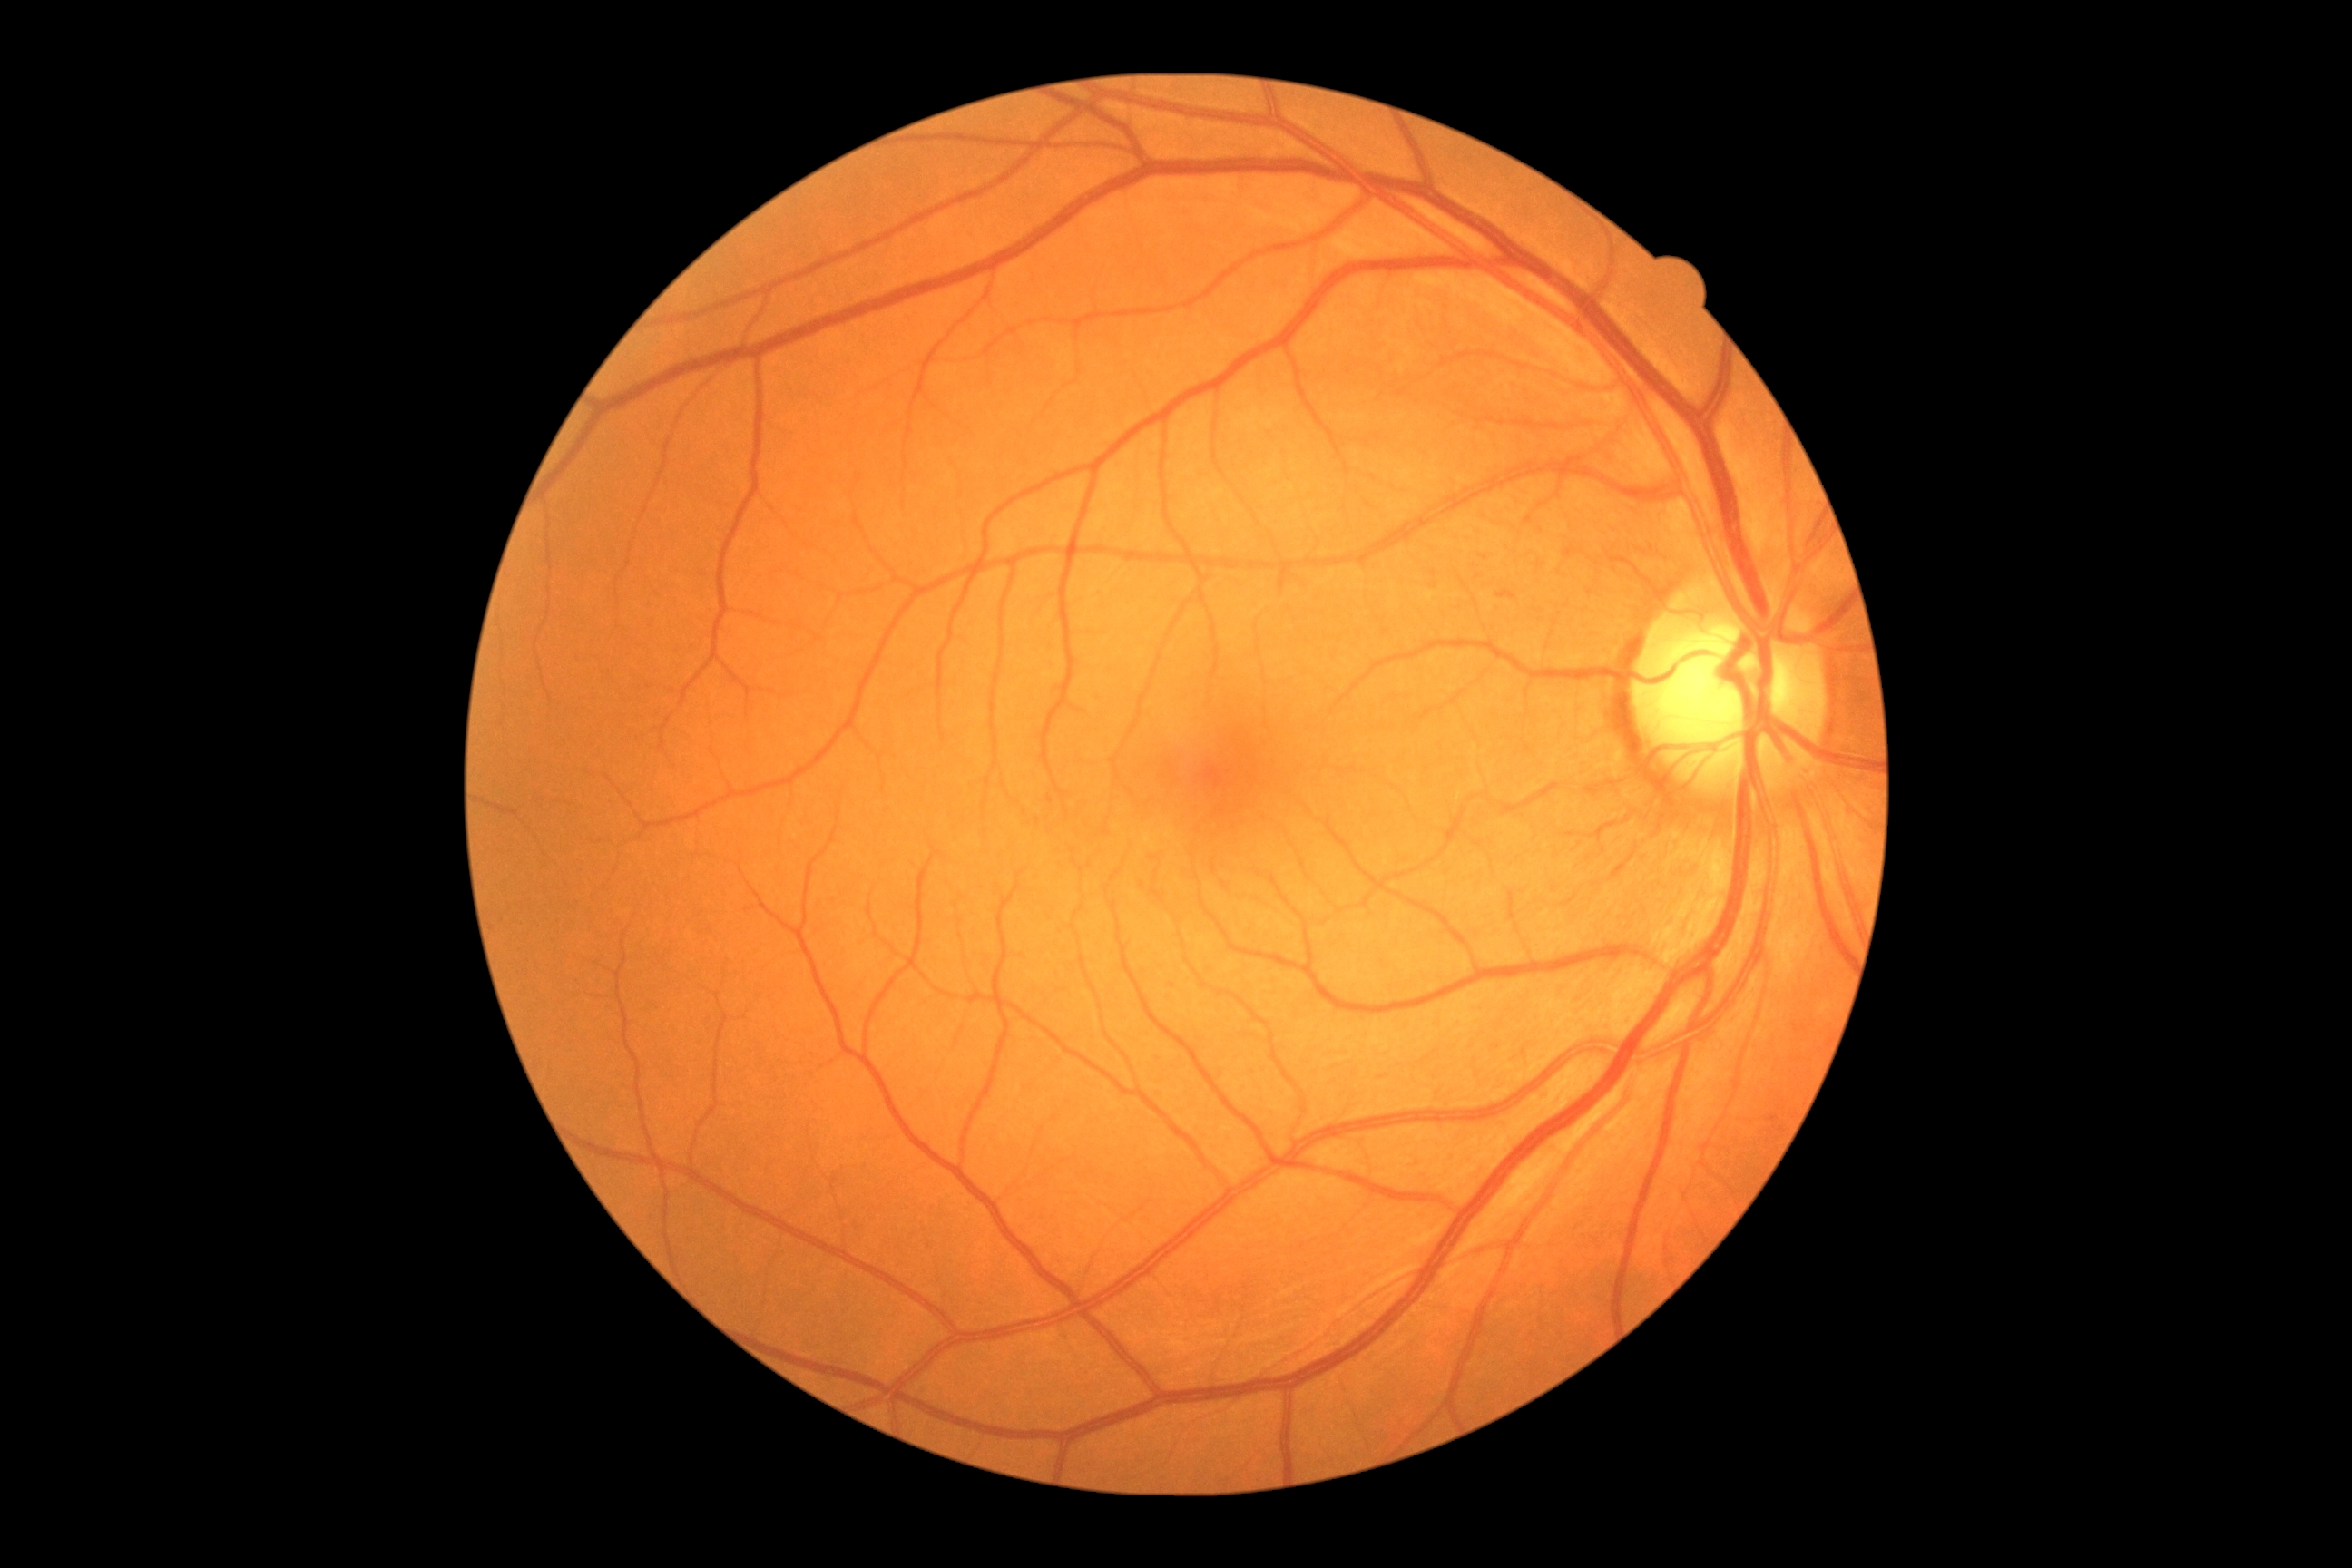 Diabetic retinopathy (DR) is 1 — presence of microaneurysms only.
The retinopathy is classified as non-proliferative diabetic retinopathy.